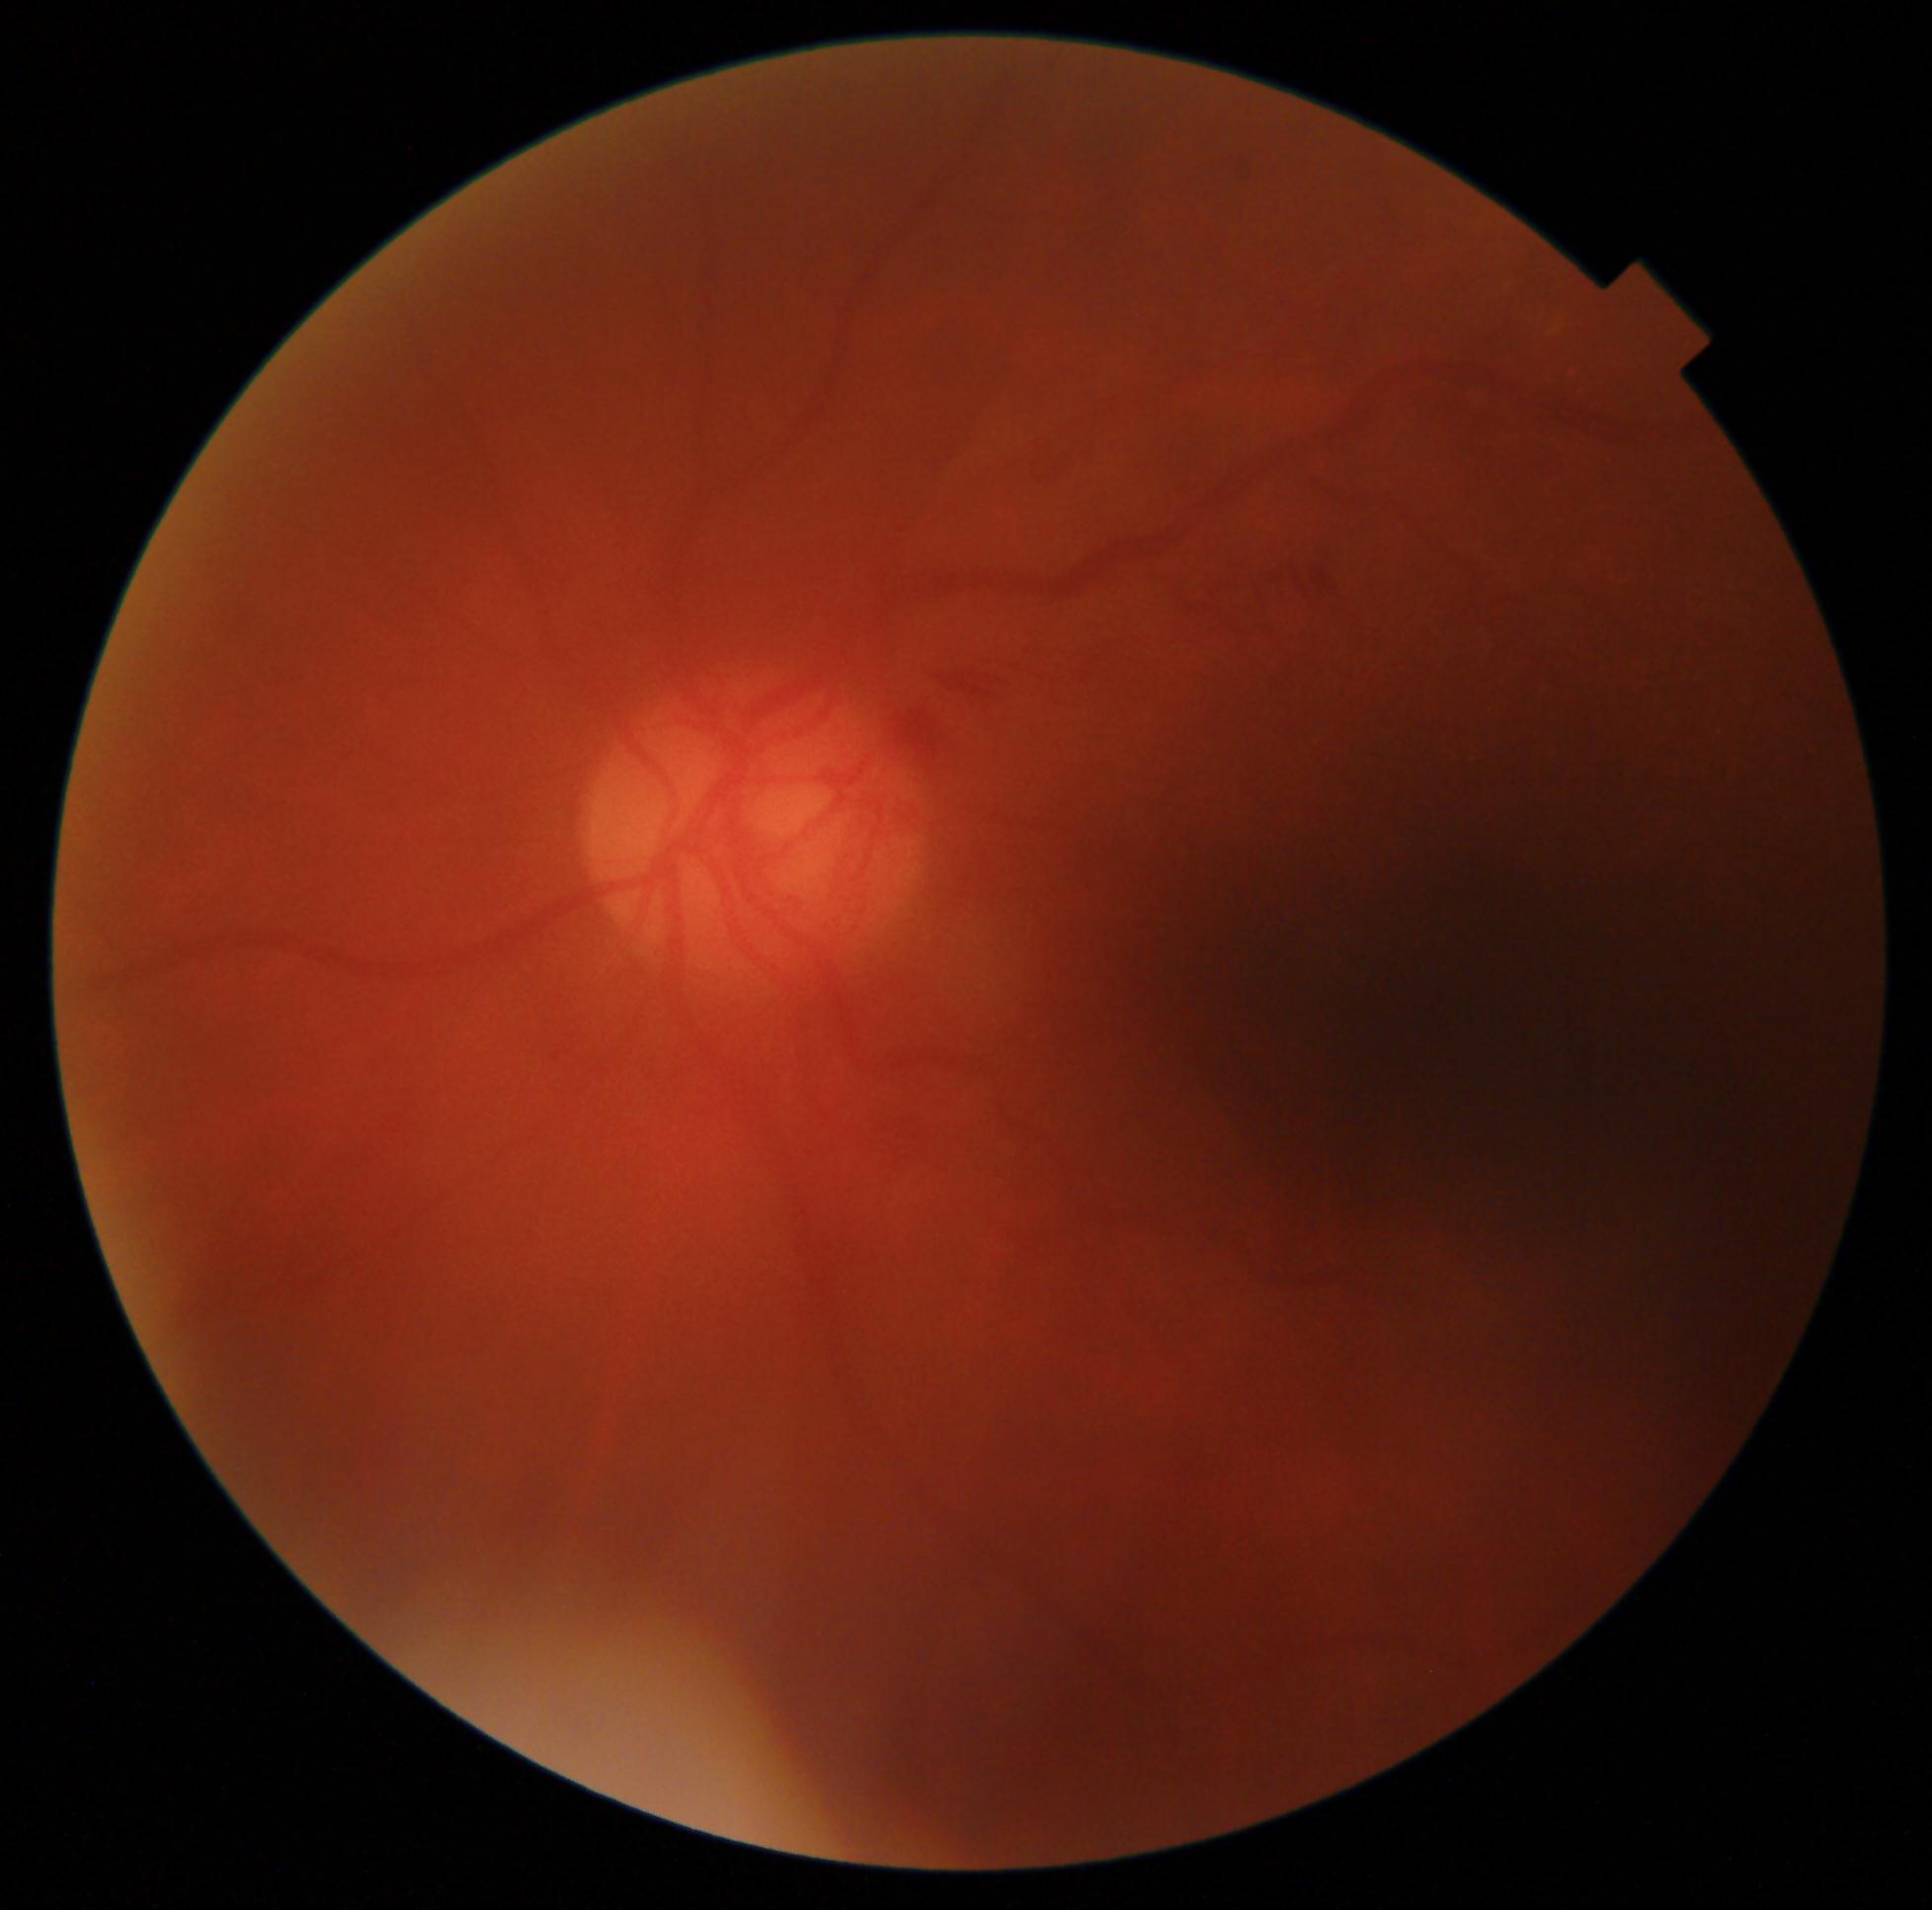
Retinopathy grade is 4 (PDR).